Without pupil dilation · 45-degree field of view · acquired with a NIDEK AFC-230 · 848 x 848 pixels · diabetic retinopathy graded by the modified Davis classification · CFP
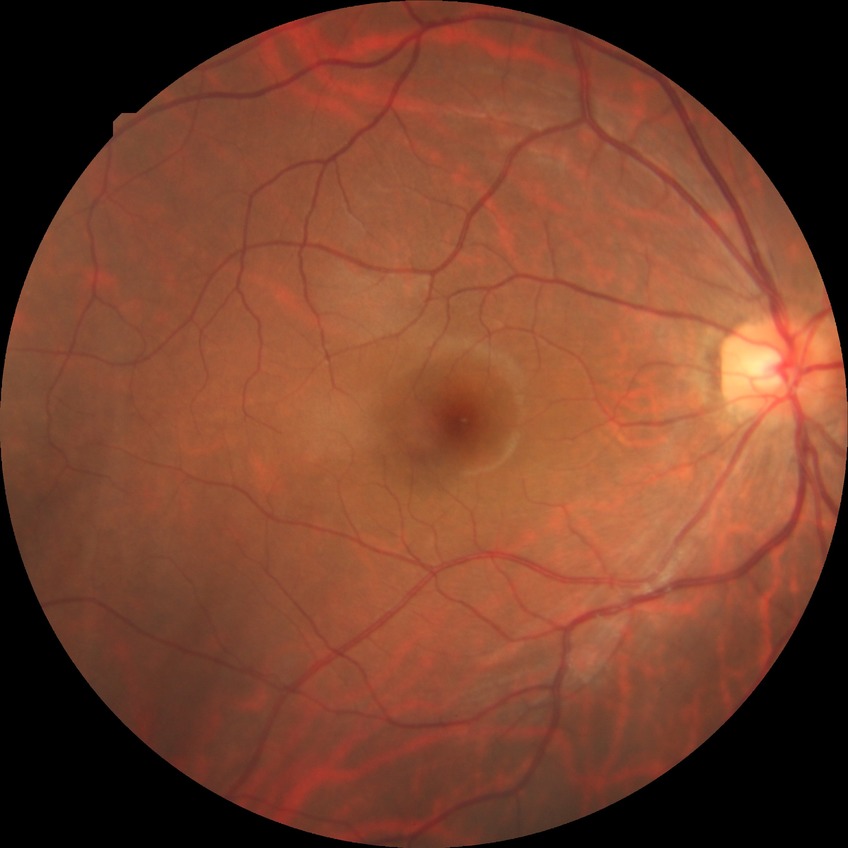 Annotations:
- diabetic retinopathy (DR): no diabetic retinopathy (NDR)